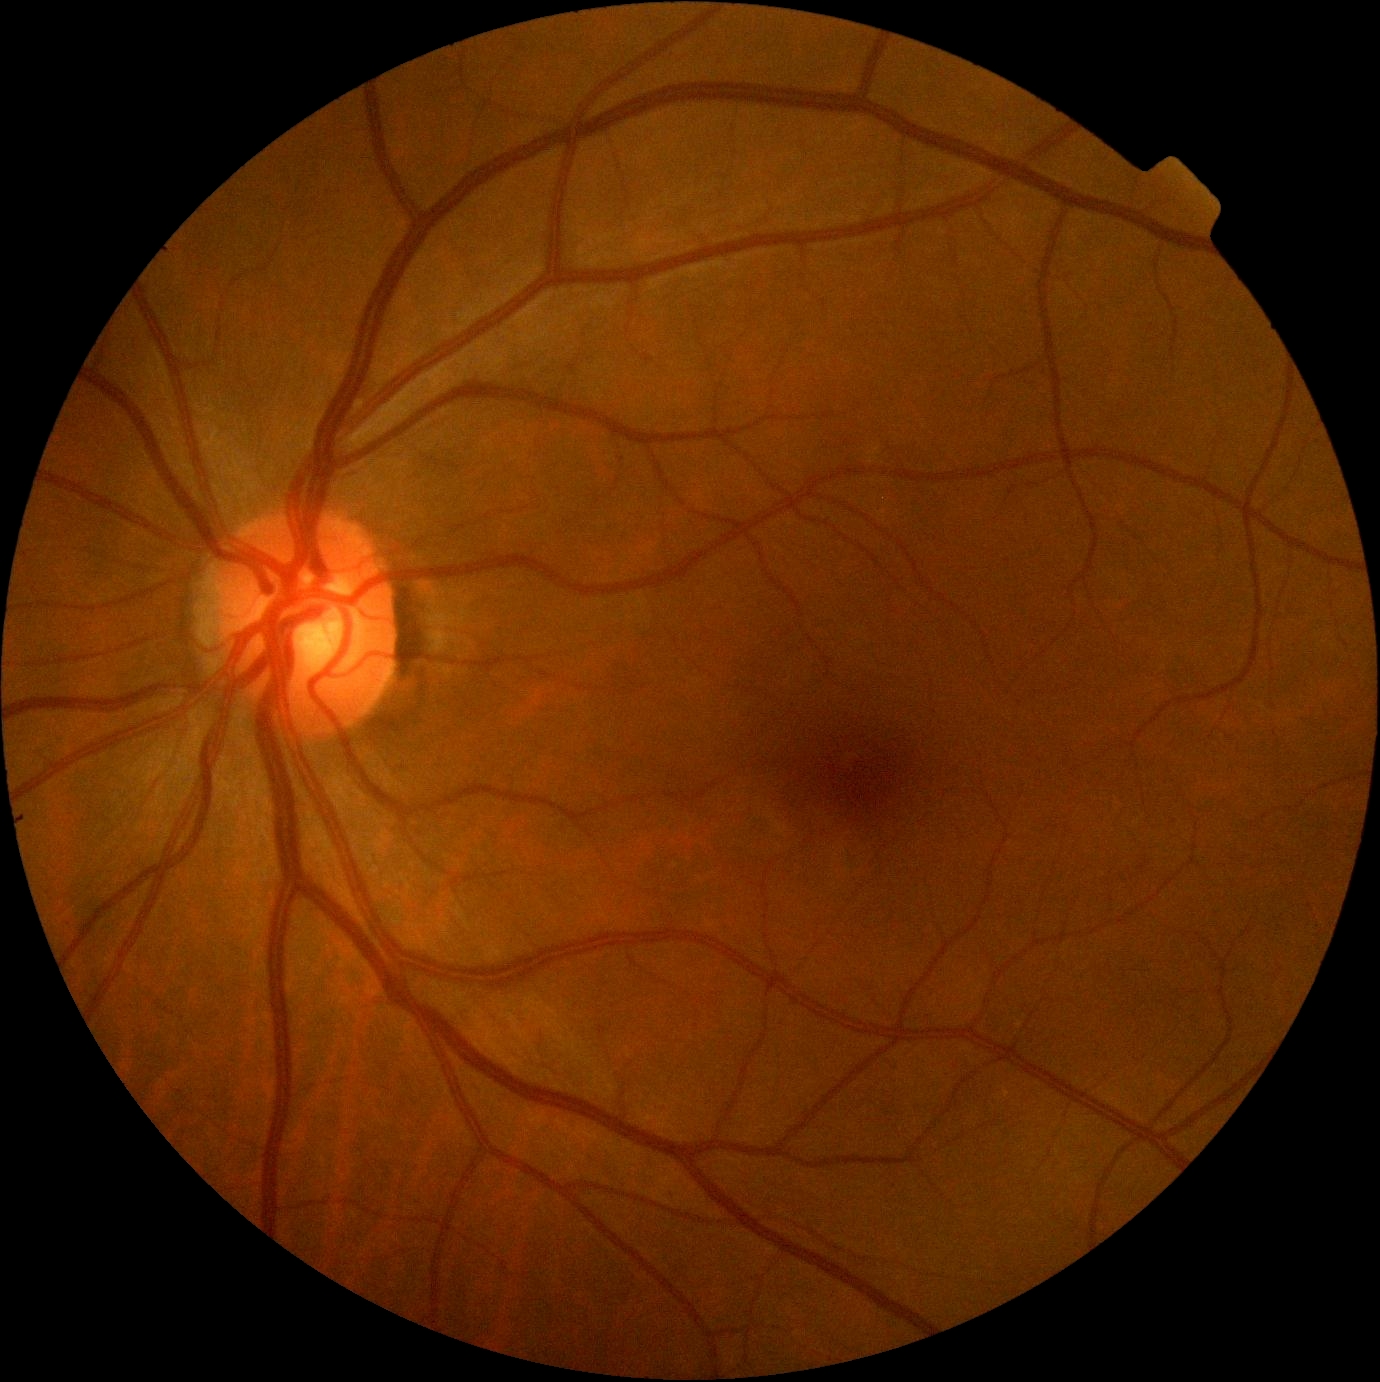
{
  "dr_grade": "0/4"
}